Clarity RetCam 3, 130° FOV; image size 640x480; pediatric retinal photograph (wide-field):
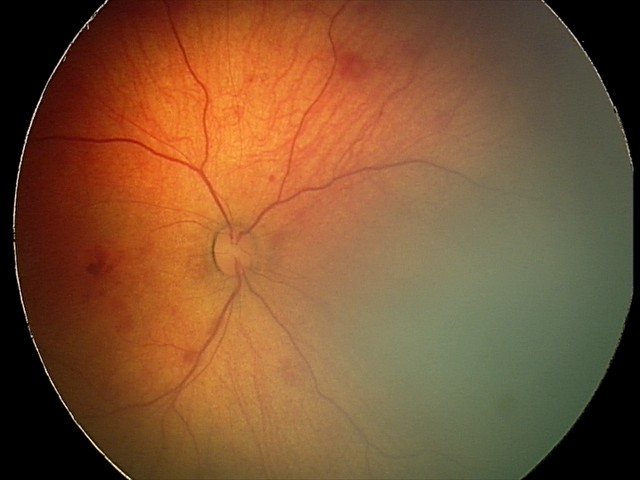

Diagnosis from this screening exam: retinal hemorrhages.